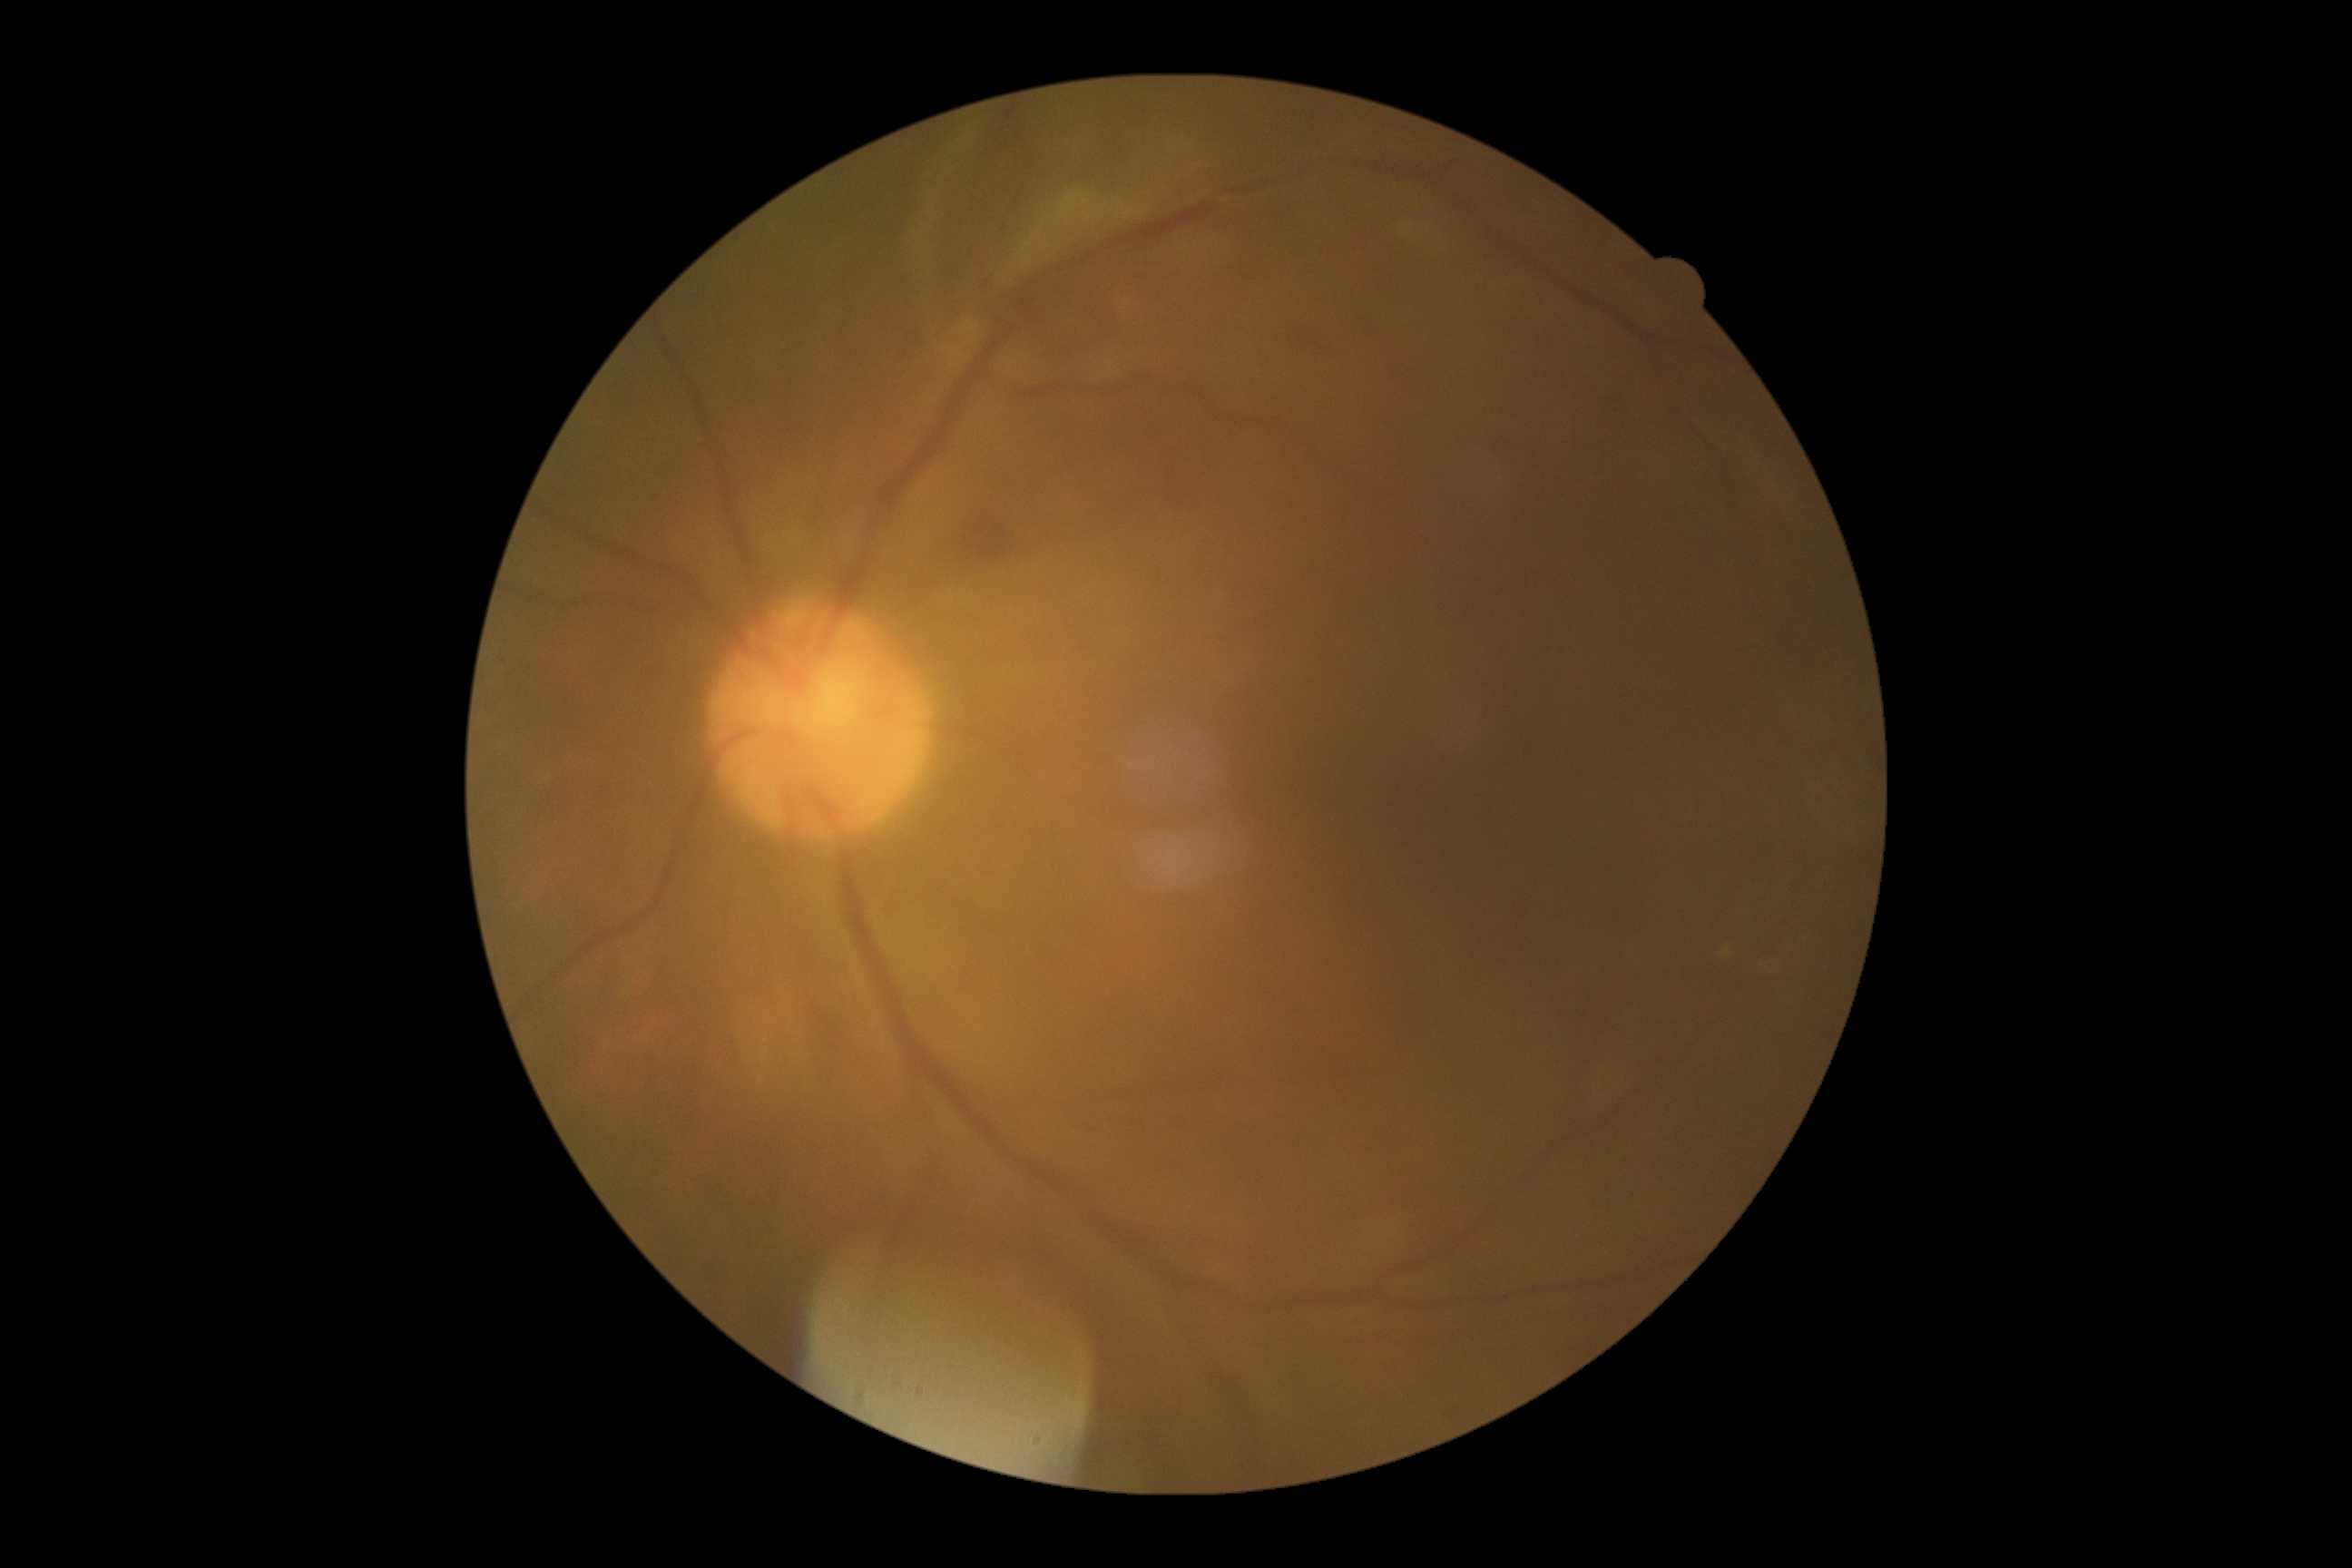 DR class=non-proliferative diabetic retinopathy, retinopathy grade=2 (moderate NPDR).